CFP.
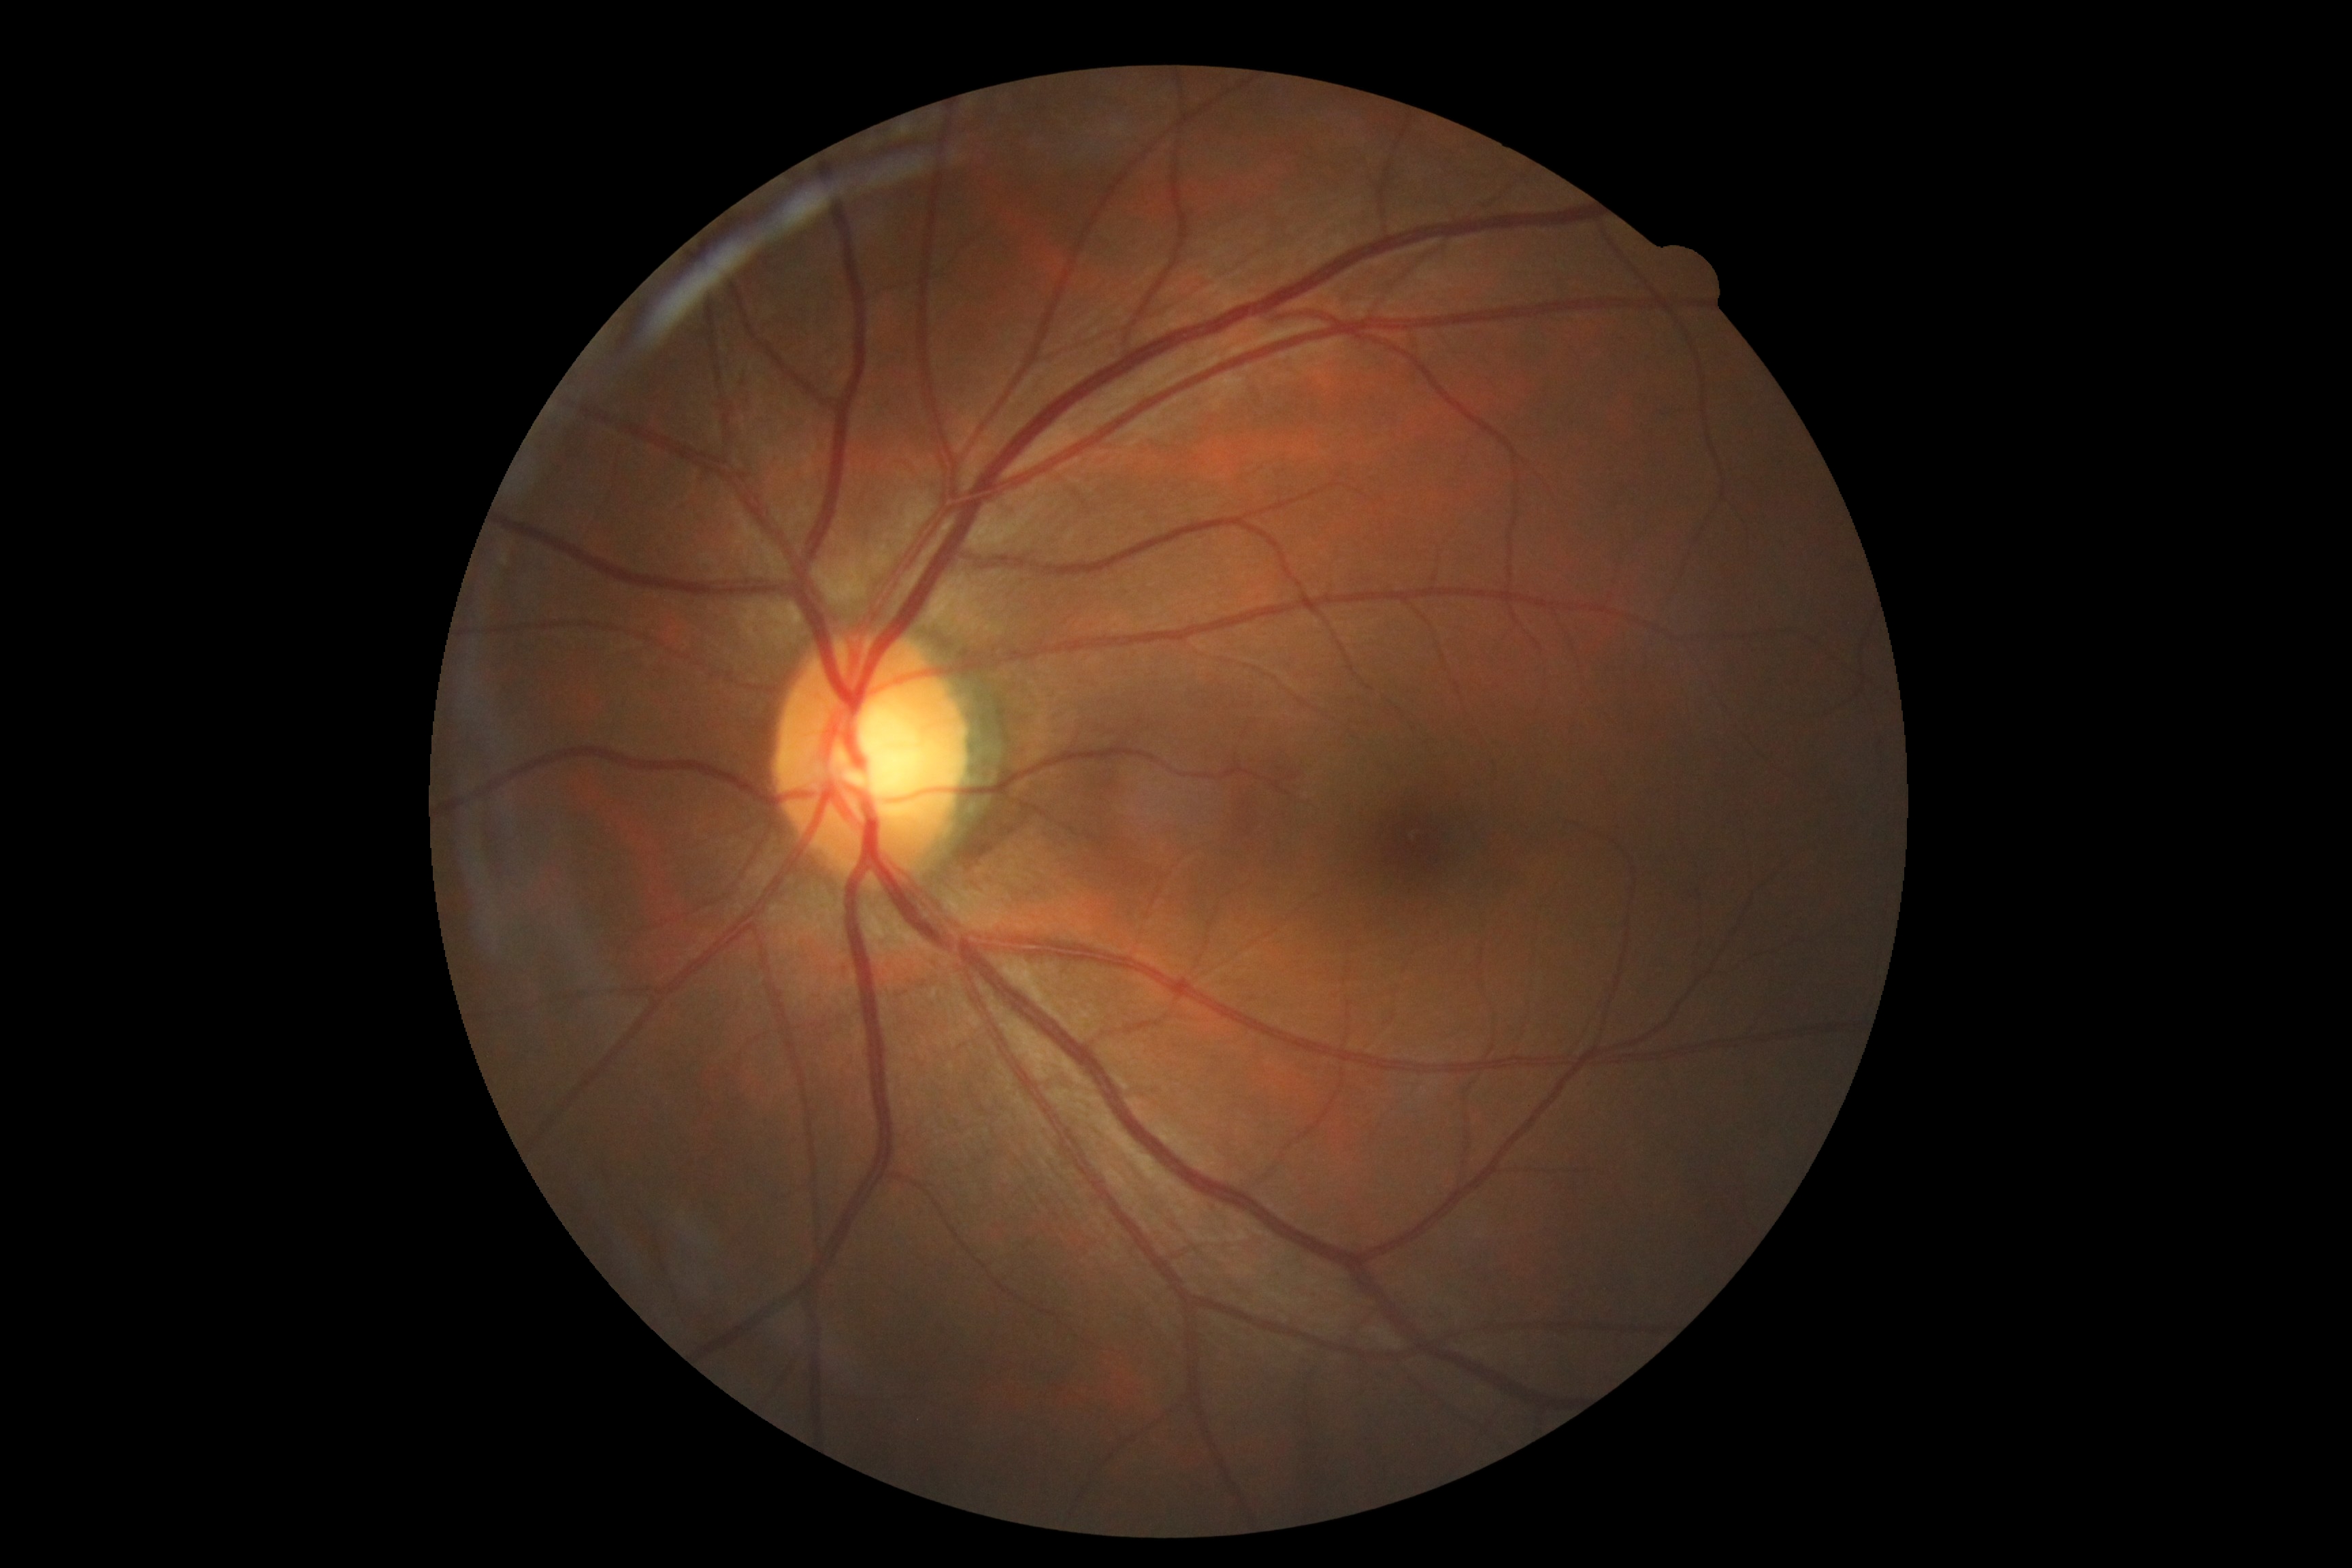 diabetic retinopathy severity: no apparent diabetic retinopathy (grade 0) — no visible signs of diabetic retinopathy, DR impression: no signs of DR.